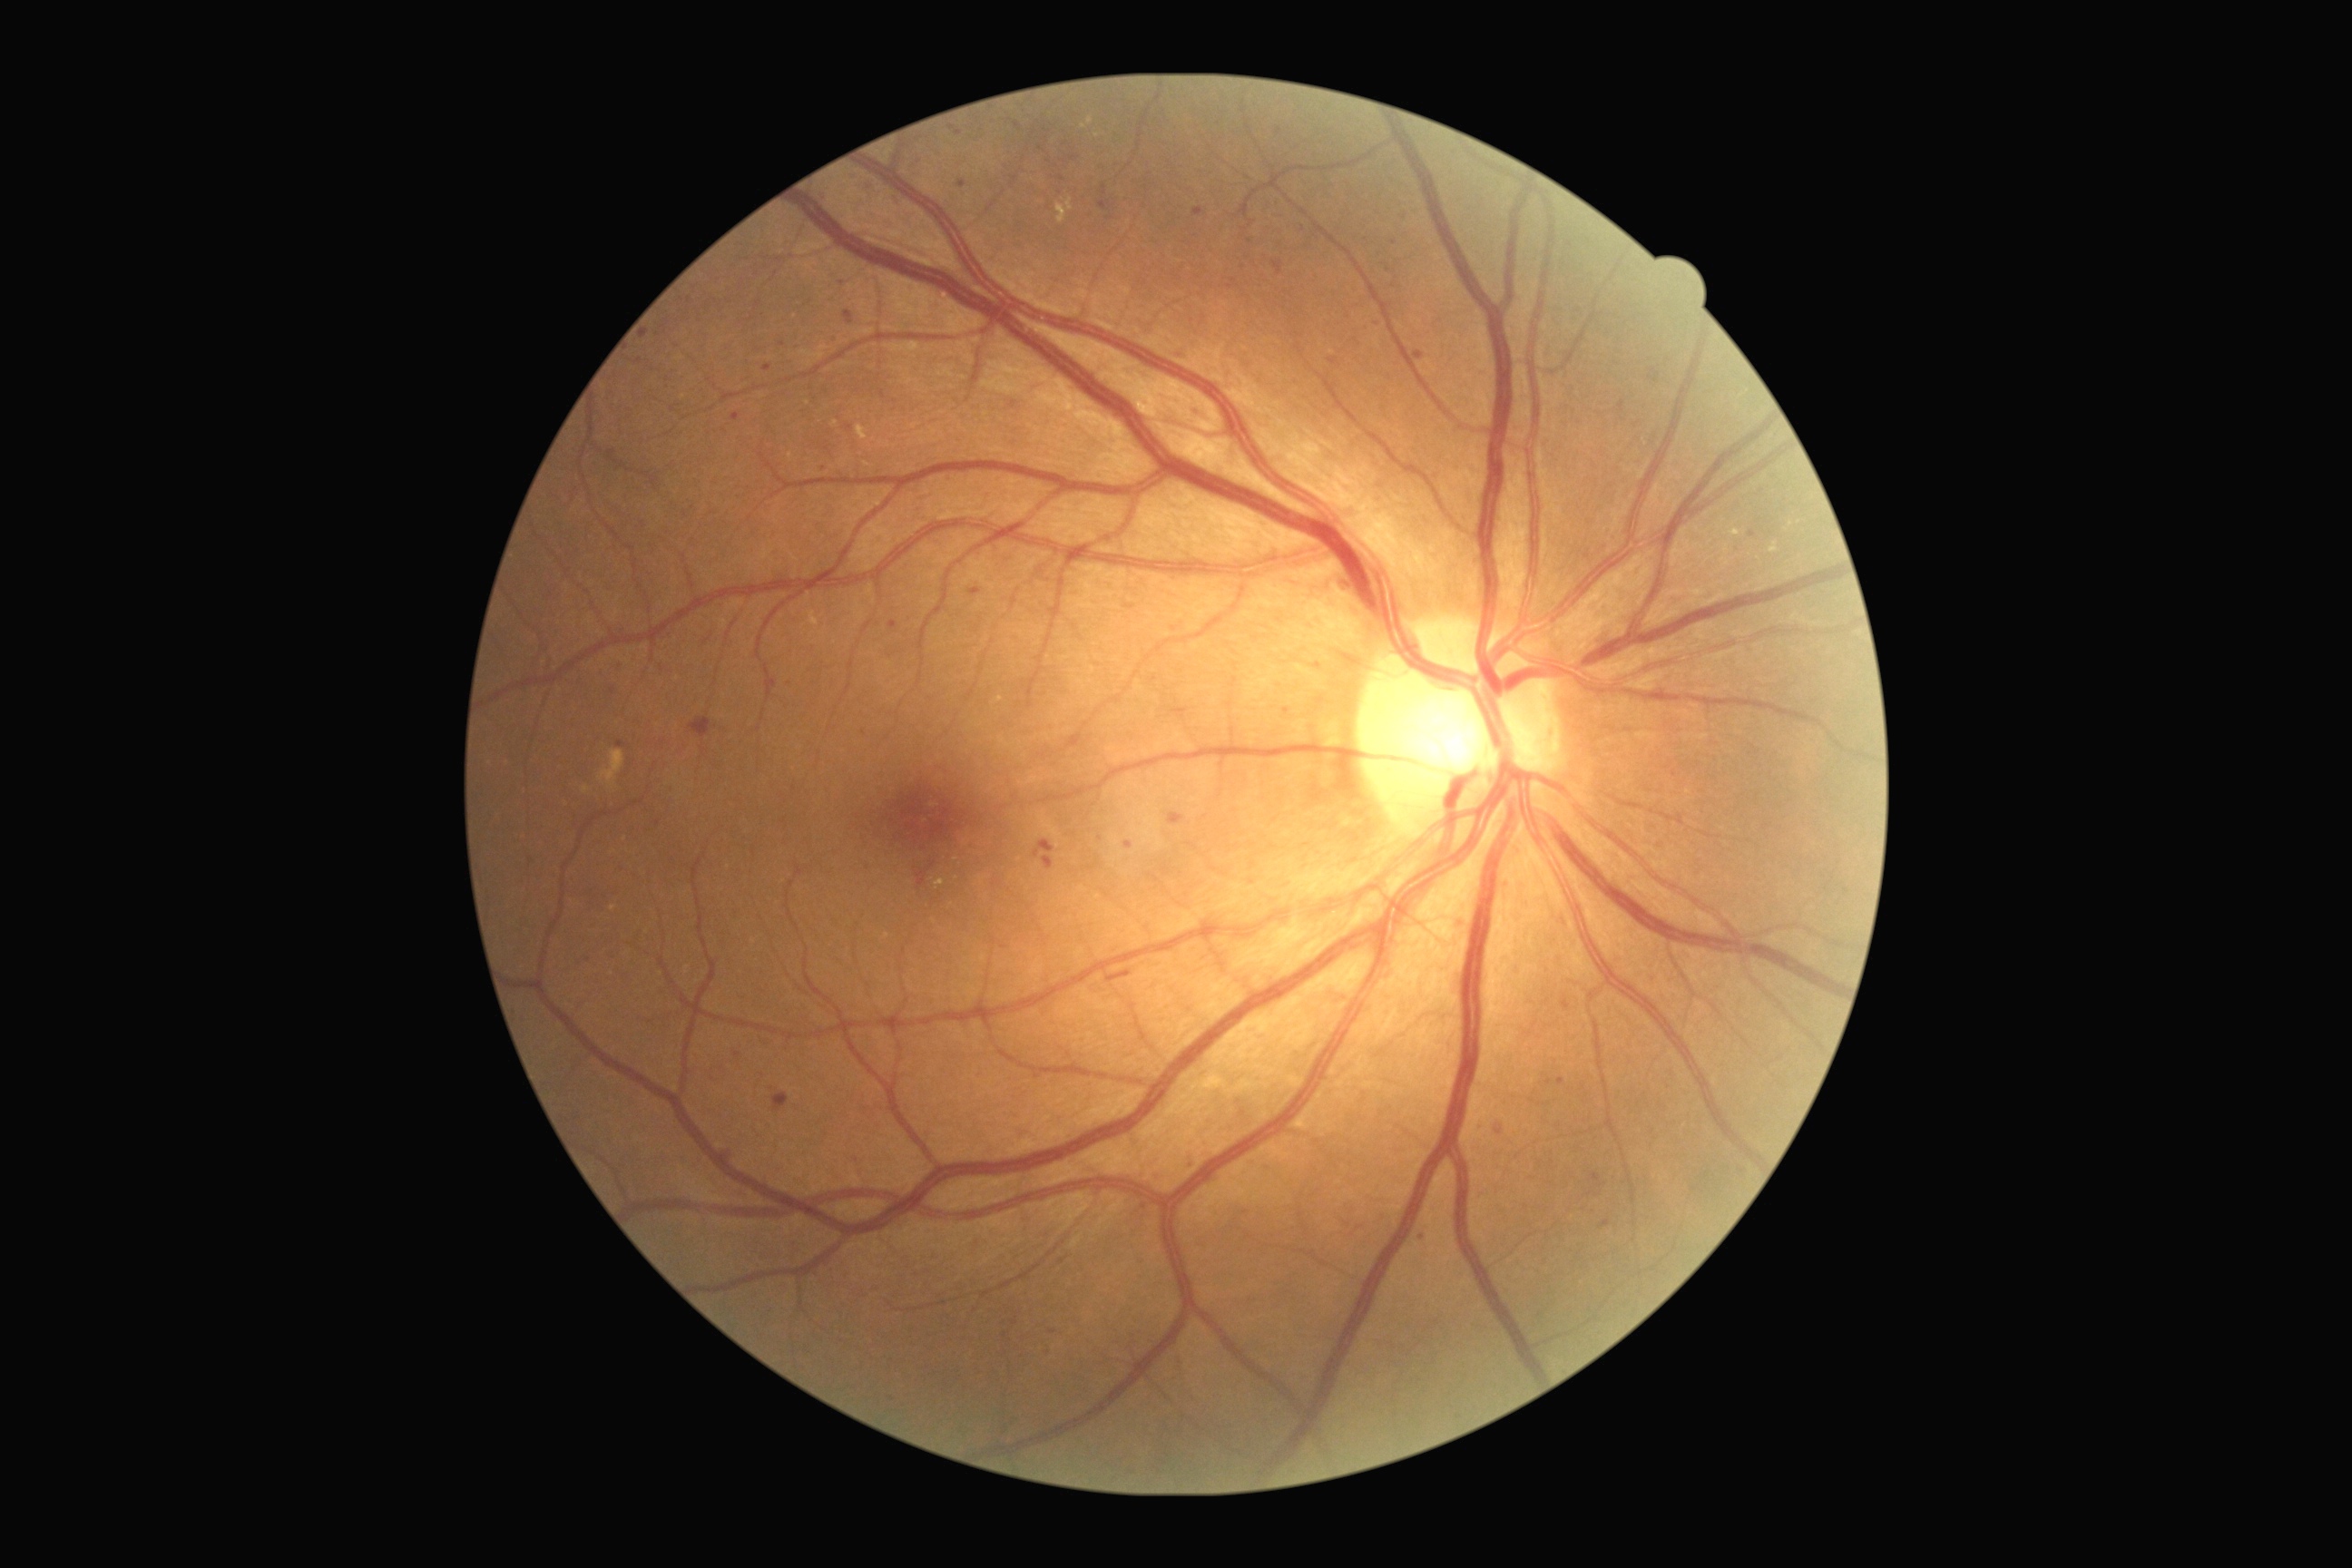 {"partial": true, "dr_grade": 2, "lesions": {"se": null, "ma": [[970, 589, 981, 596], [888, 622, 897, 629], [1591, 1171, 1602, 1182], [718, 1152, 732, 1166], [1034, 1072, 1046, 1079], [1102, 186, 1108, 197], [1193, 208, 1204, 217], [1124, 843, 1133, 848]], "ma_small_centers": [[850, 428], [1394, 243], [619, 666], [1318, 668], [1550, 1083], [737, 1055], [1047, 1351], [1250, 241]], "ex": [[1055, 199, 1073, 224], [858, 426, 868, 442], [995, 696, 1003, 703], [936, 879, 945, 888]], "he": [[1168, 812, 1184, 825], [1106, 970, 1132, 983], [689, 718, 710, 738], [1034, 839, 1055, 859], [772, 1093, 790, 1113], [1126, 605, 1135, 609], [1273, 262, 1284, 275], [1044, 856, 1055, 870], [843, 311, 854, 326]]}}